FOV: 45 degrees; NIDEK AFC-230; fundus photo: 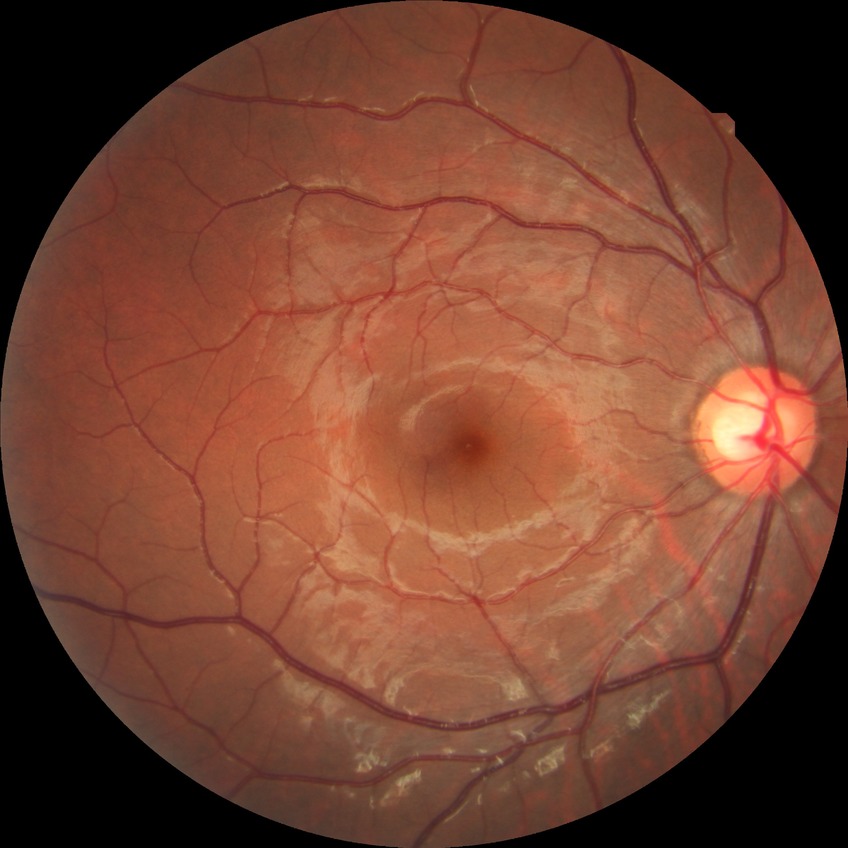
diabetic retinopathy (DR): no diabetic retinopathy (NDR).